Fundus photo · 848 by 848 pixels: 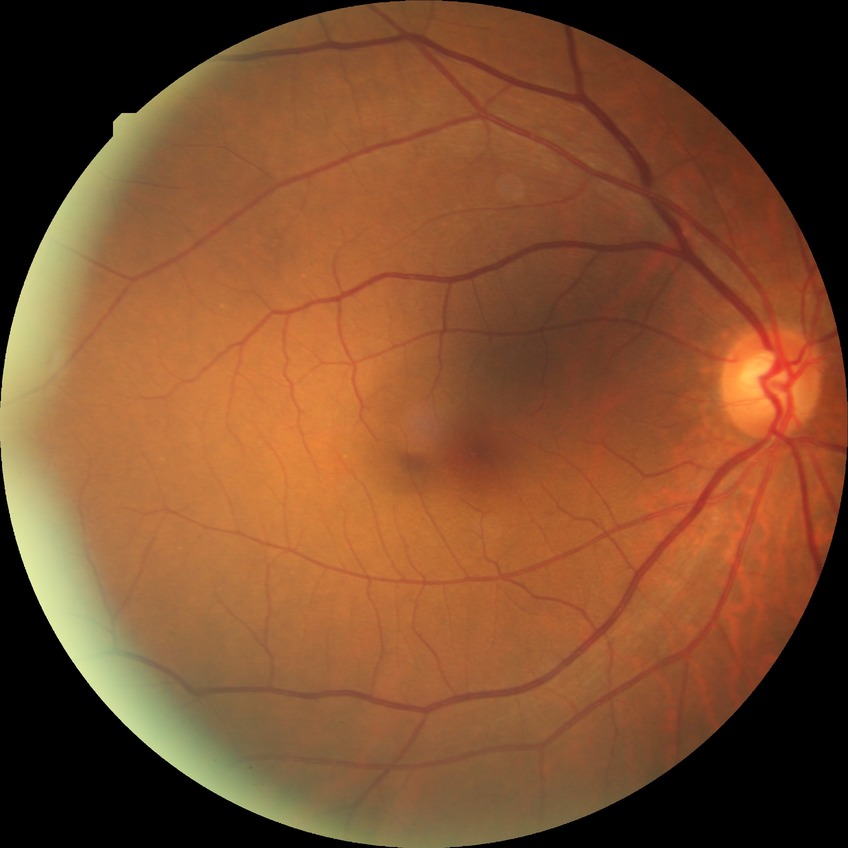

DR severity = NDR.